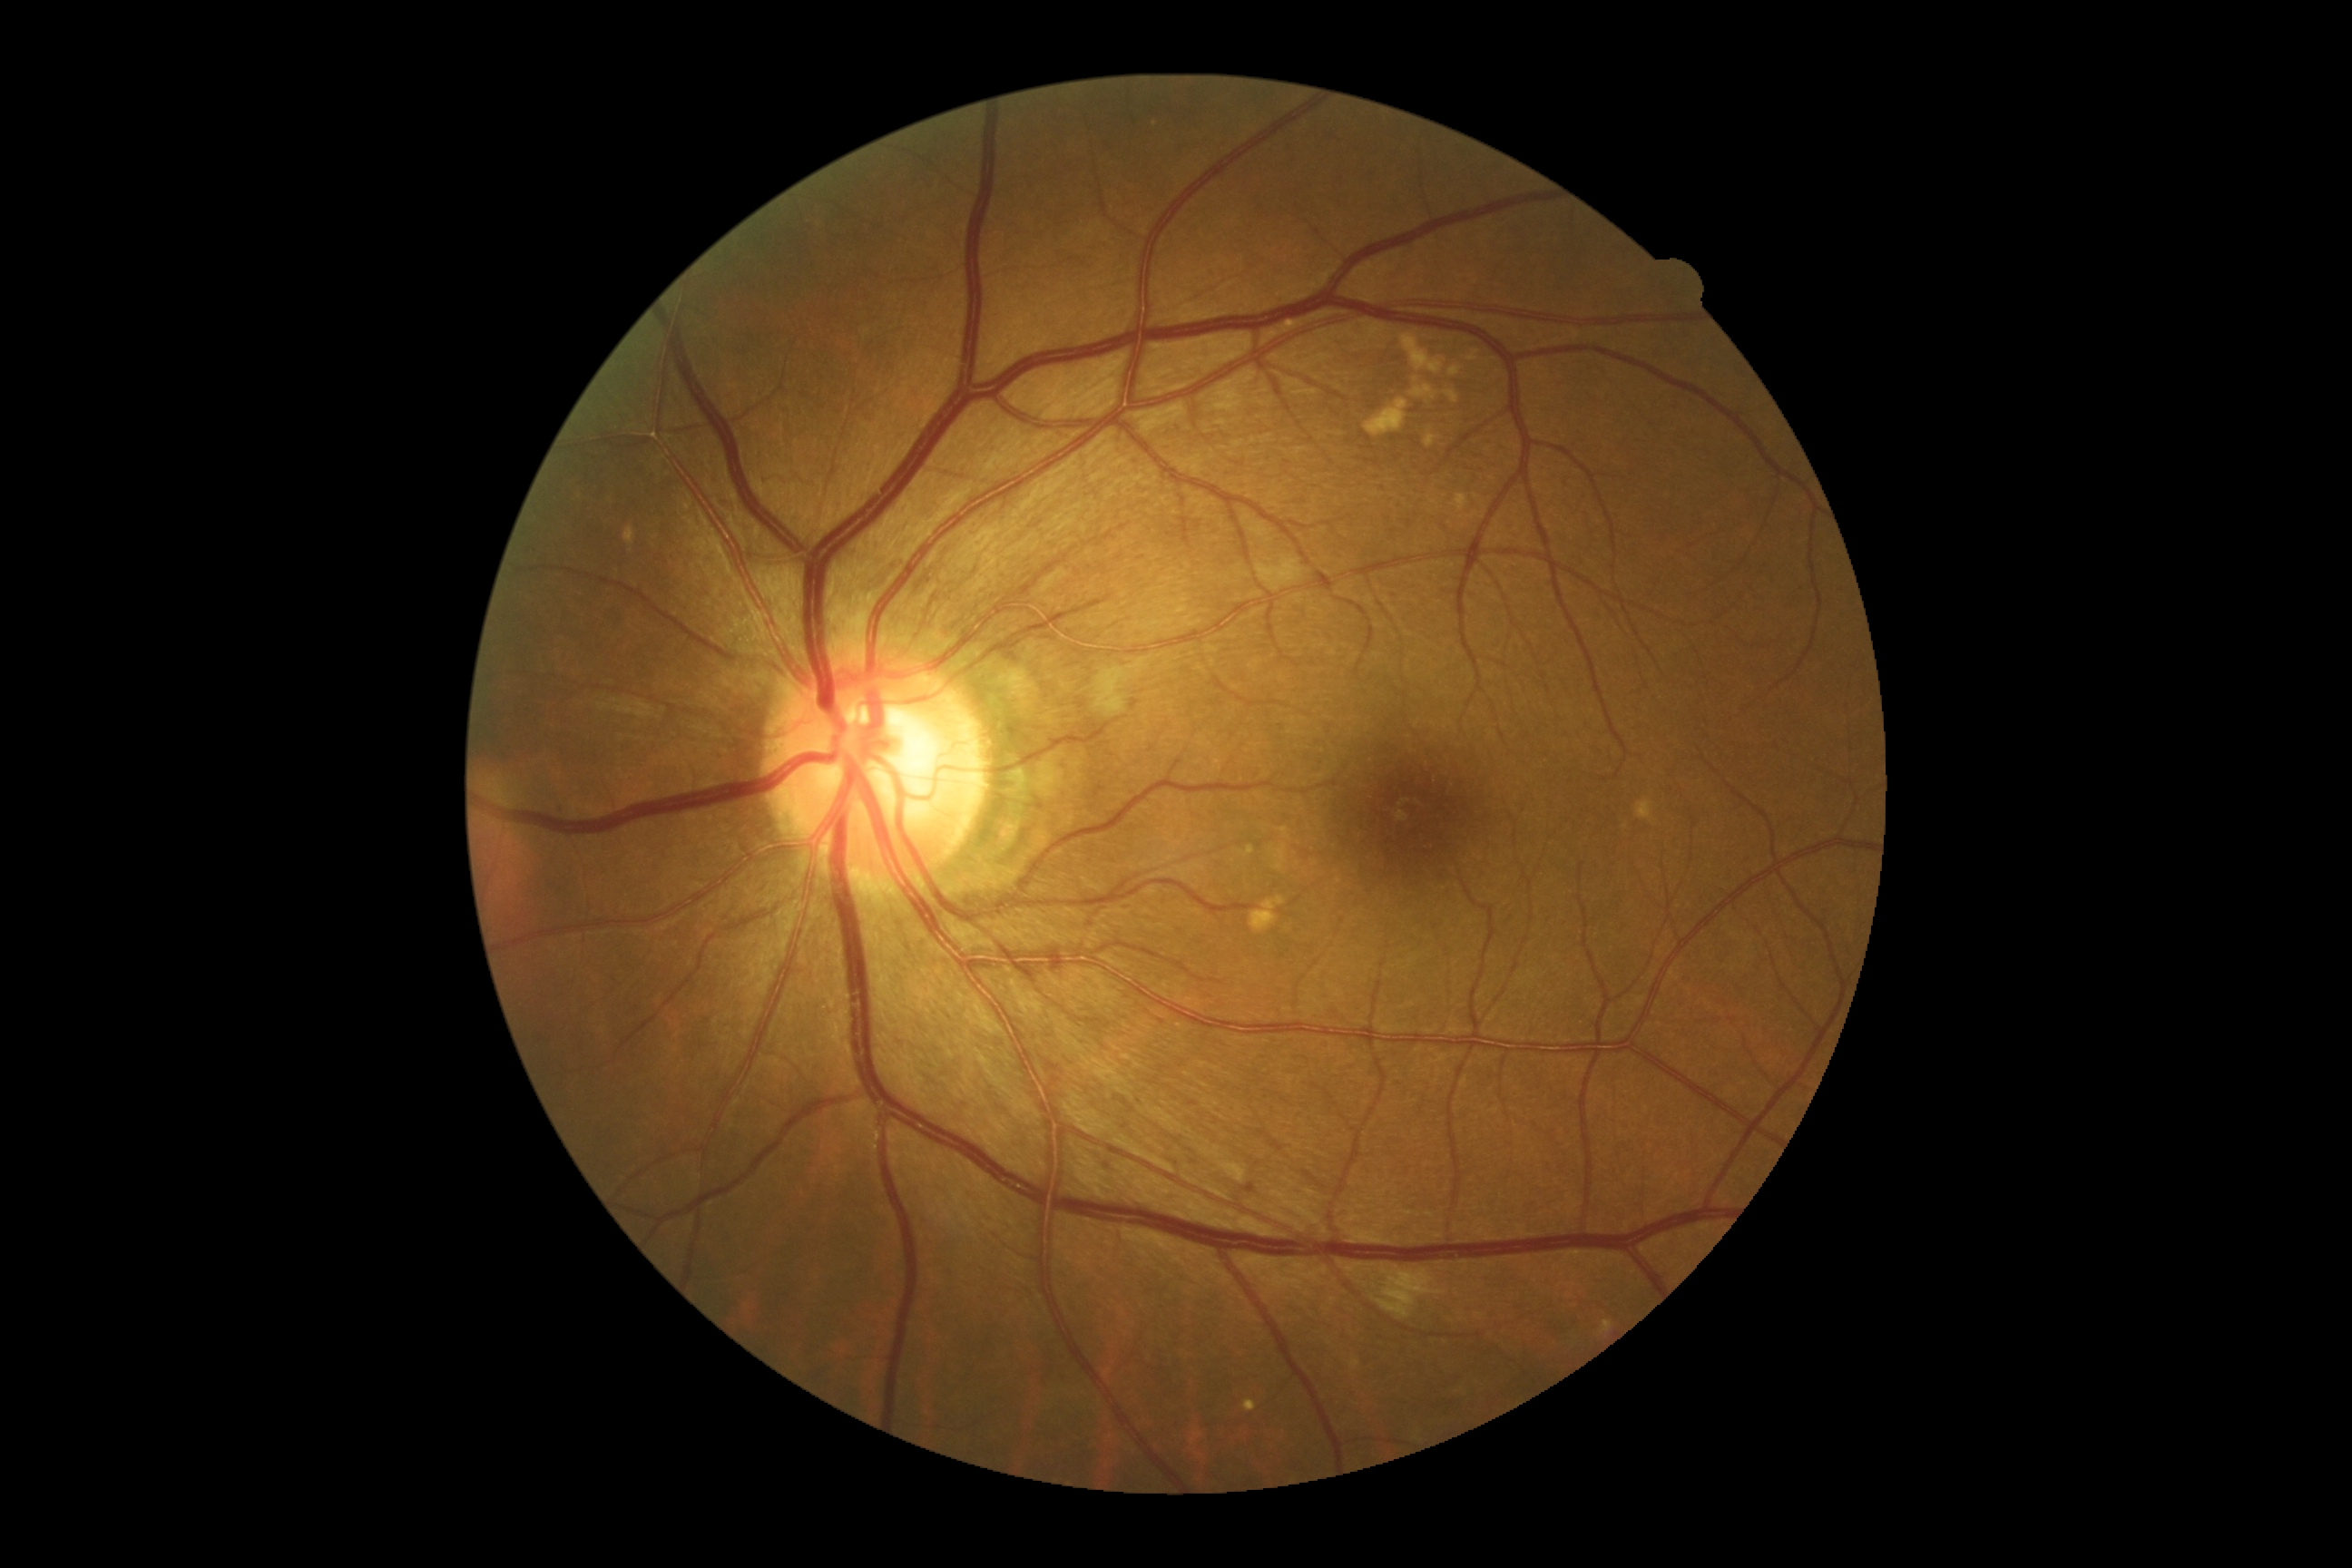
{
  "dr_grade": "2/4"
}